Infant wide-field fundus photograph — 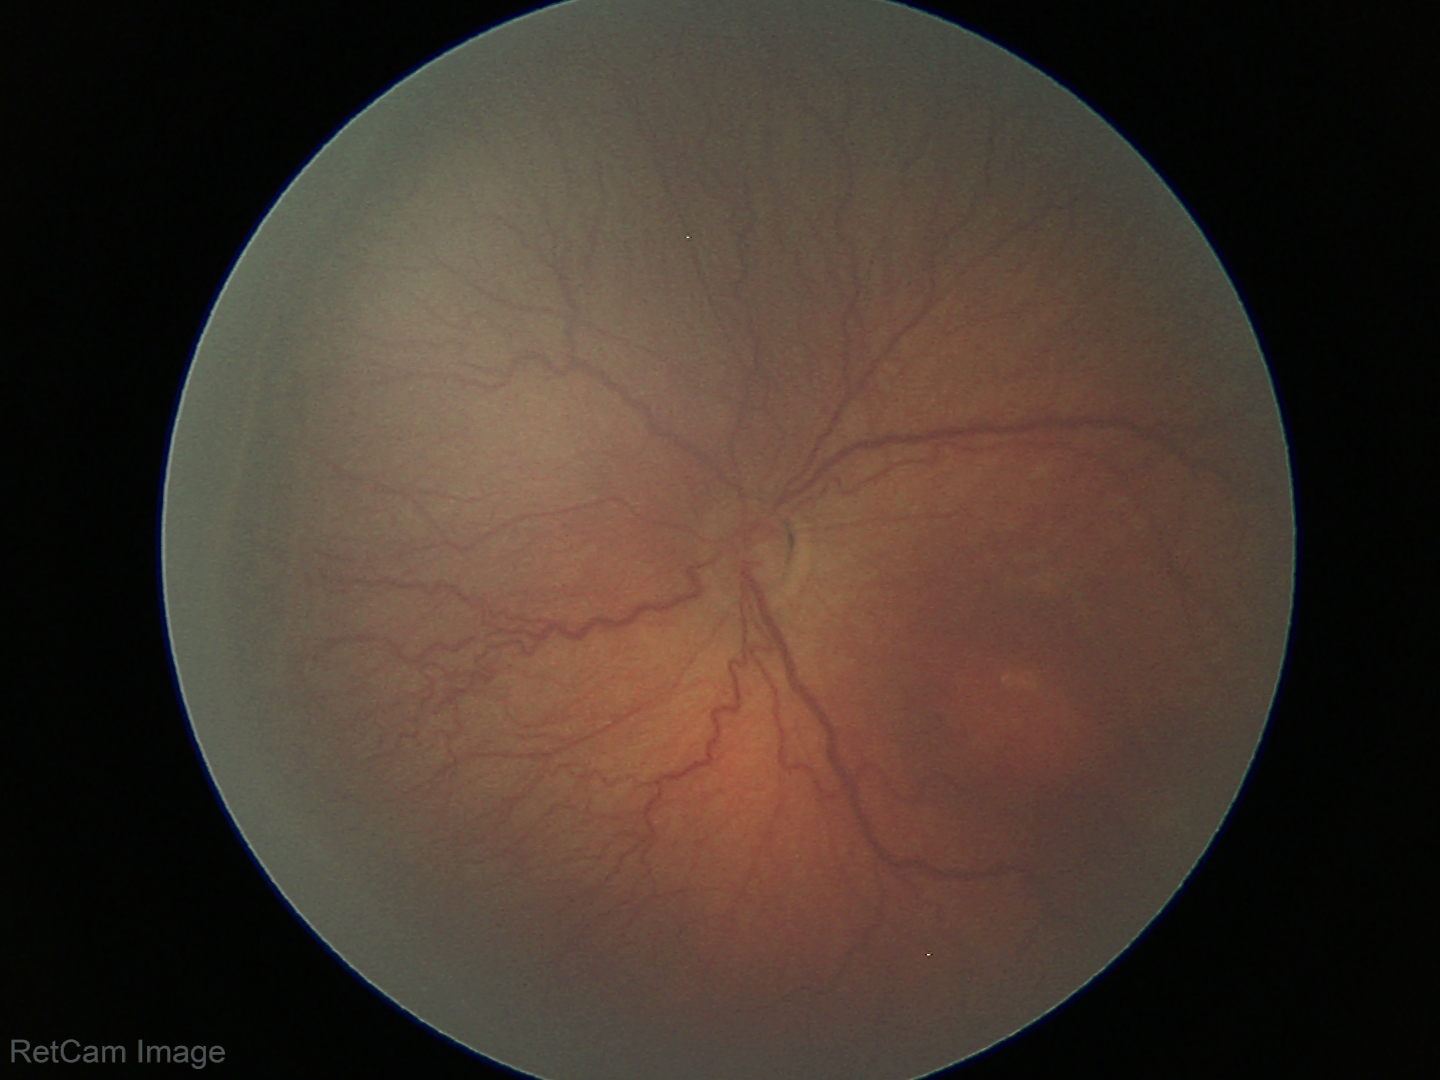 Q: What is the diagnosis from this examination?
A: ROP stage 3
Q: Is plus disease present?
A: no plus disease